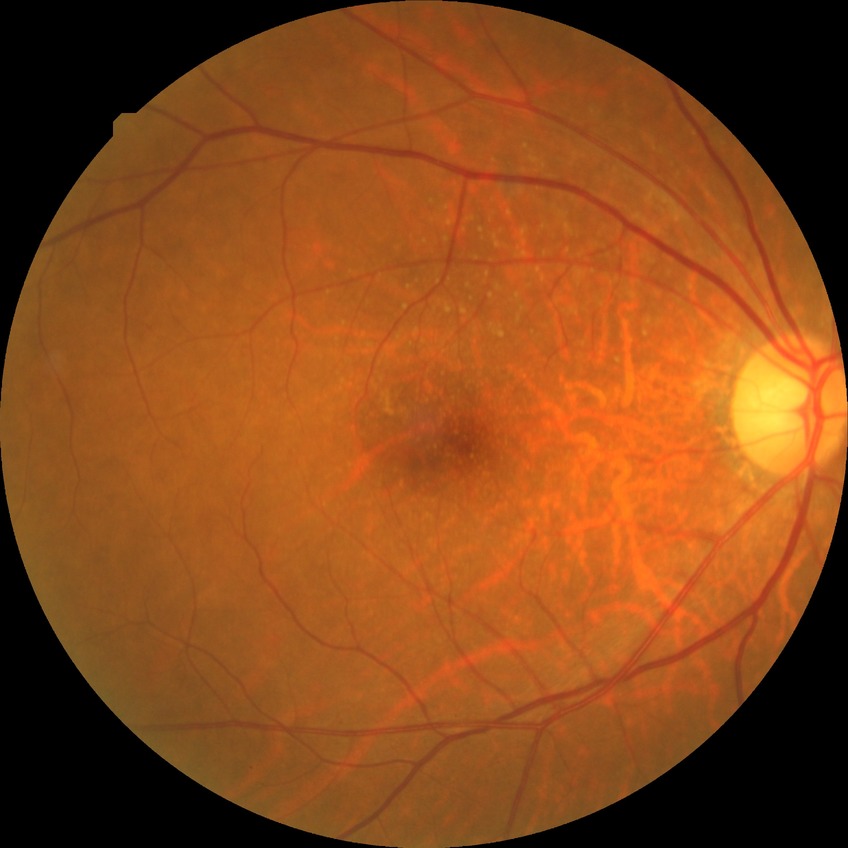

Davis grading is no diabetic retinopathy.